DR severity per modified Davis staging.
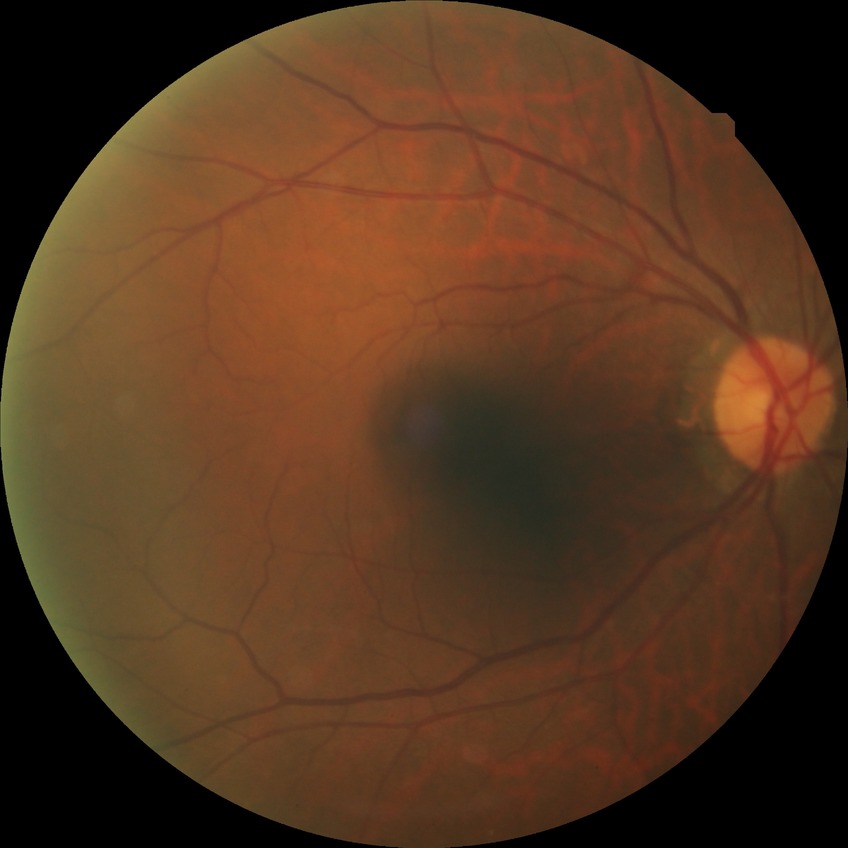

Diabetic retinopathy (DR): no diabetic retinopathy (NDR).